Fundus photo · image size 2352x1568 · 45° field of view.
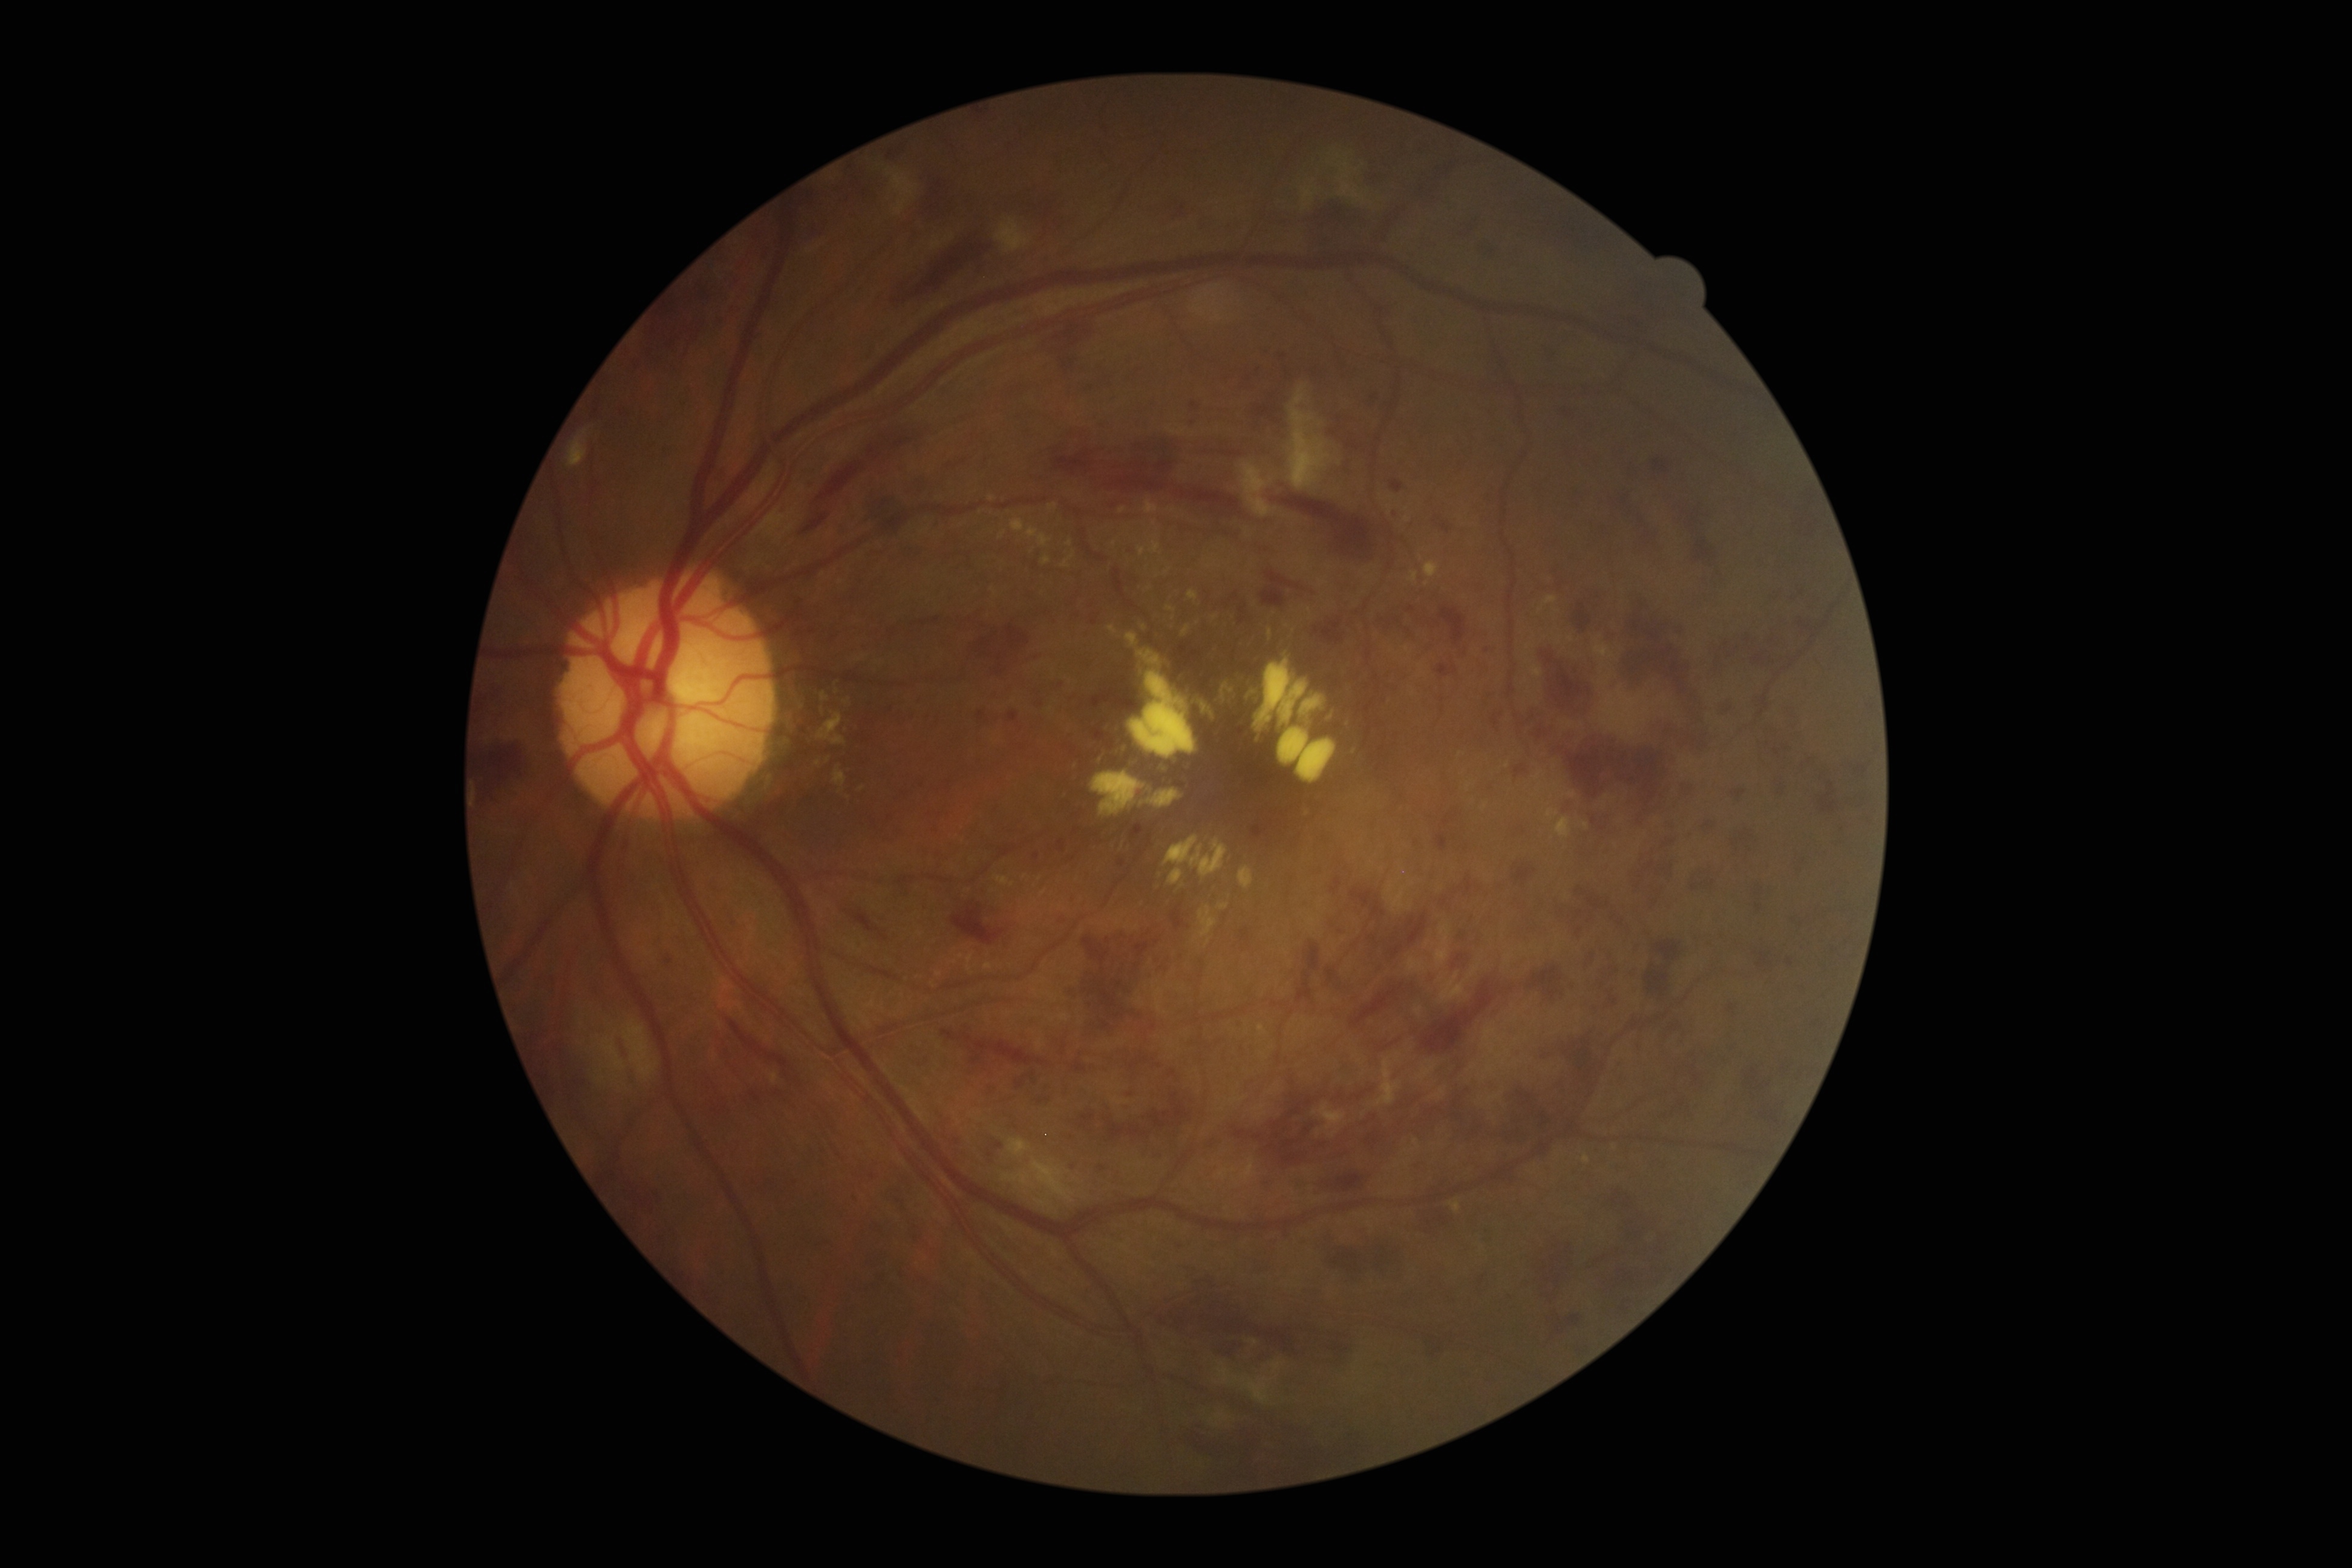

Findings:
- DR class — non-proliferative diabetic retinopathy
- retinopathy grade — 3 (severe NPDR)